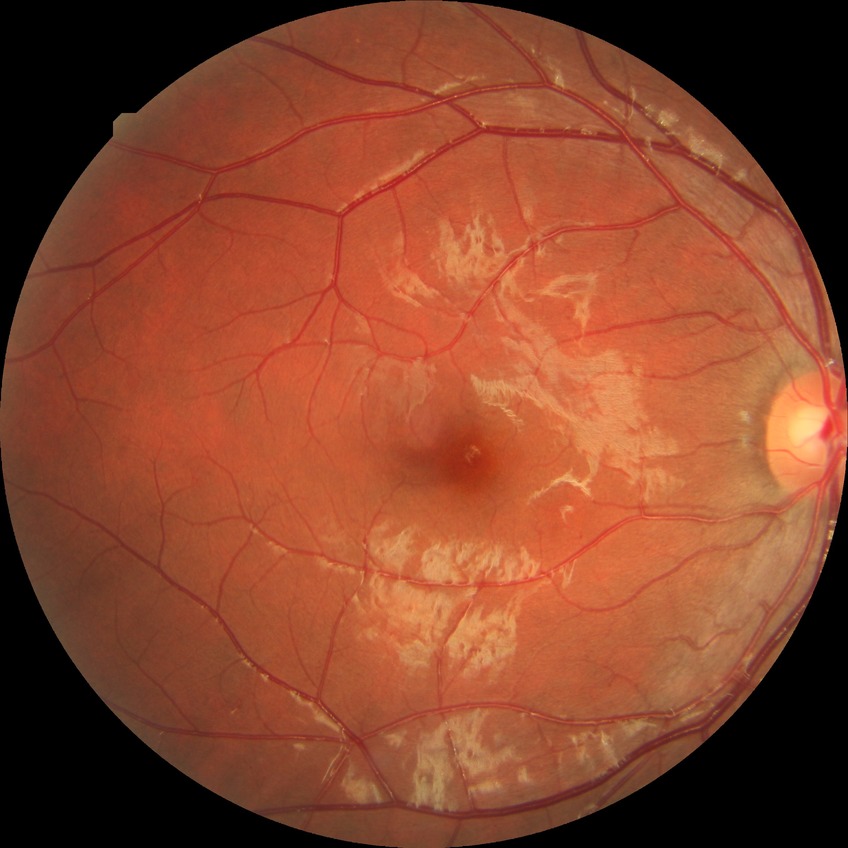   proliferative_class: non-proliferative diabetic retinopathy
  davis_grade: SDR